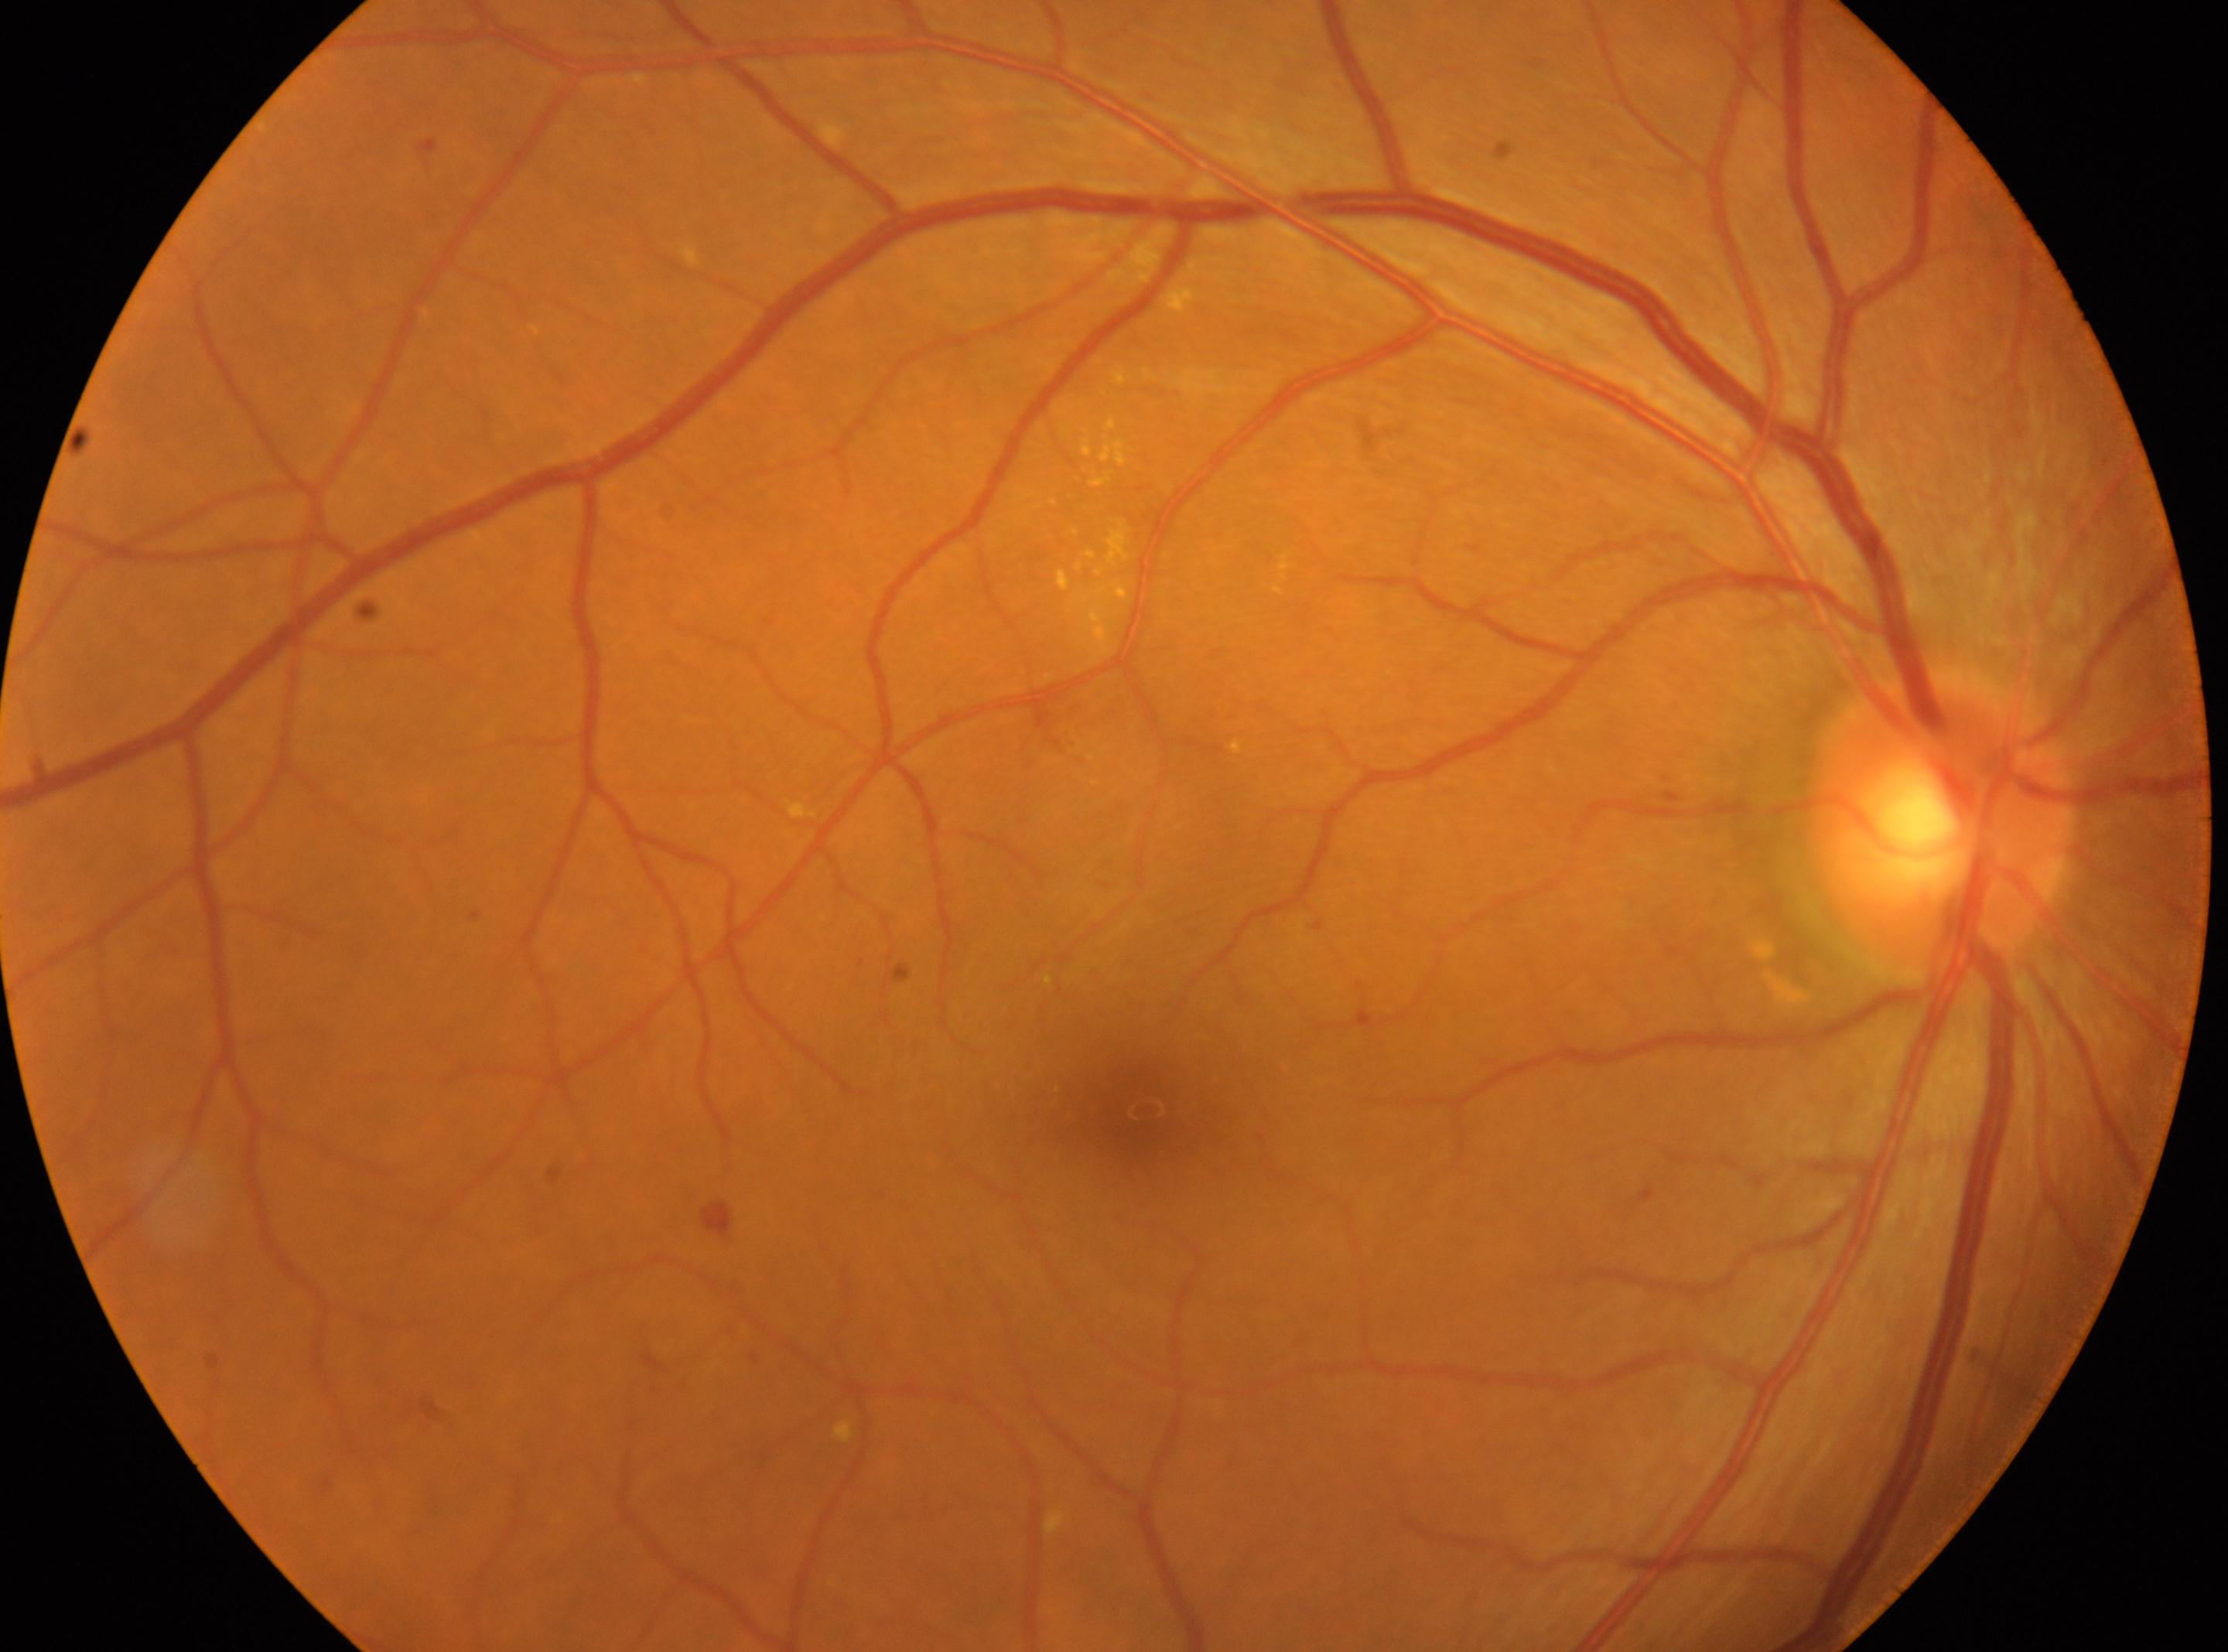 The optic nerve head is at 1941, 820. The image shows the right eye. Fovea center located at 1143, 1106. Retinopathy is 2. Disease class: non-proliferative diabetic retinopathy.